2352x1568
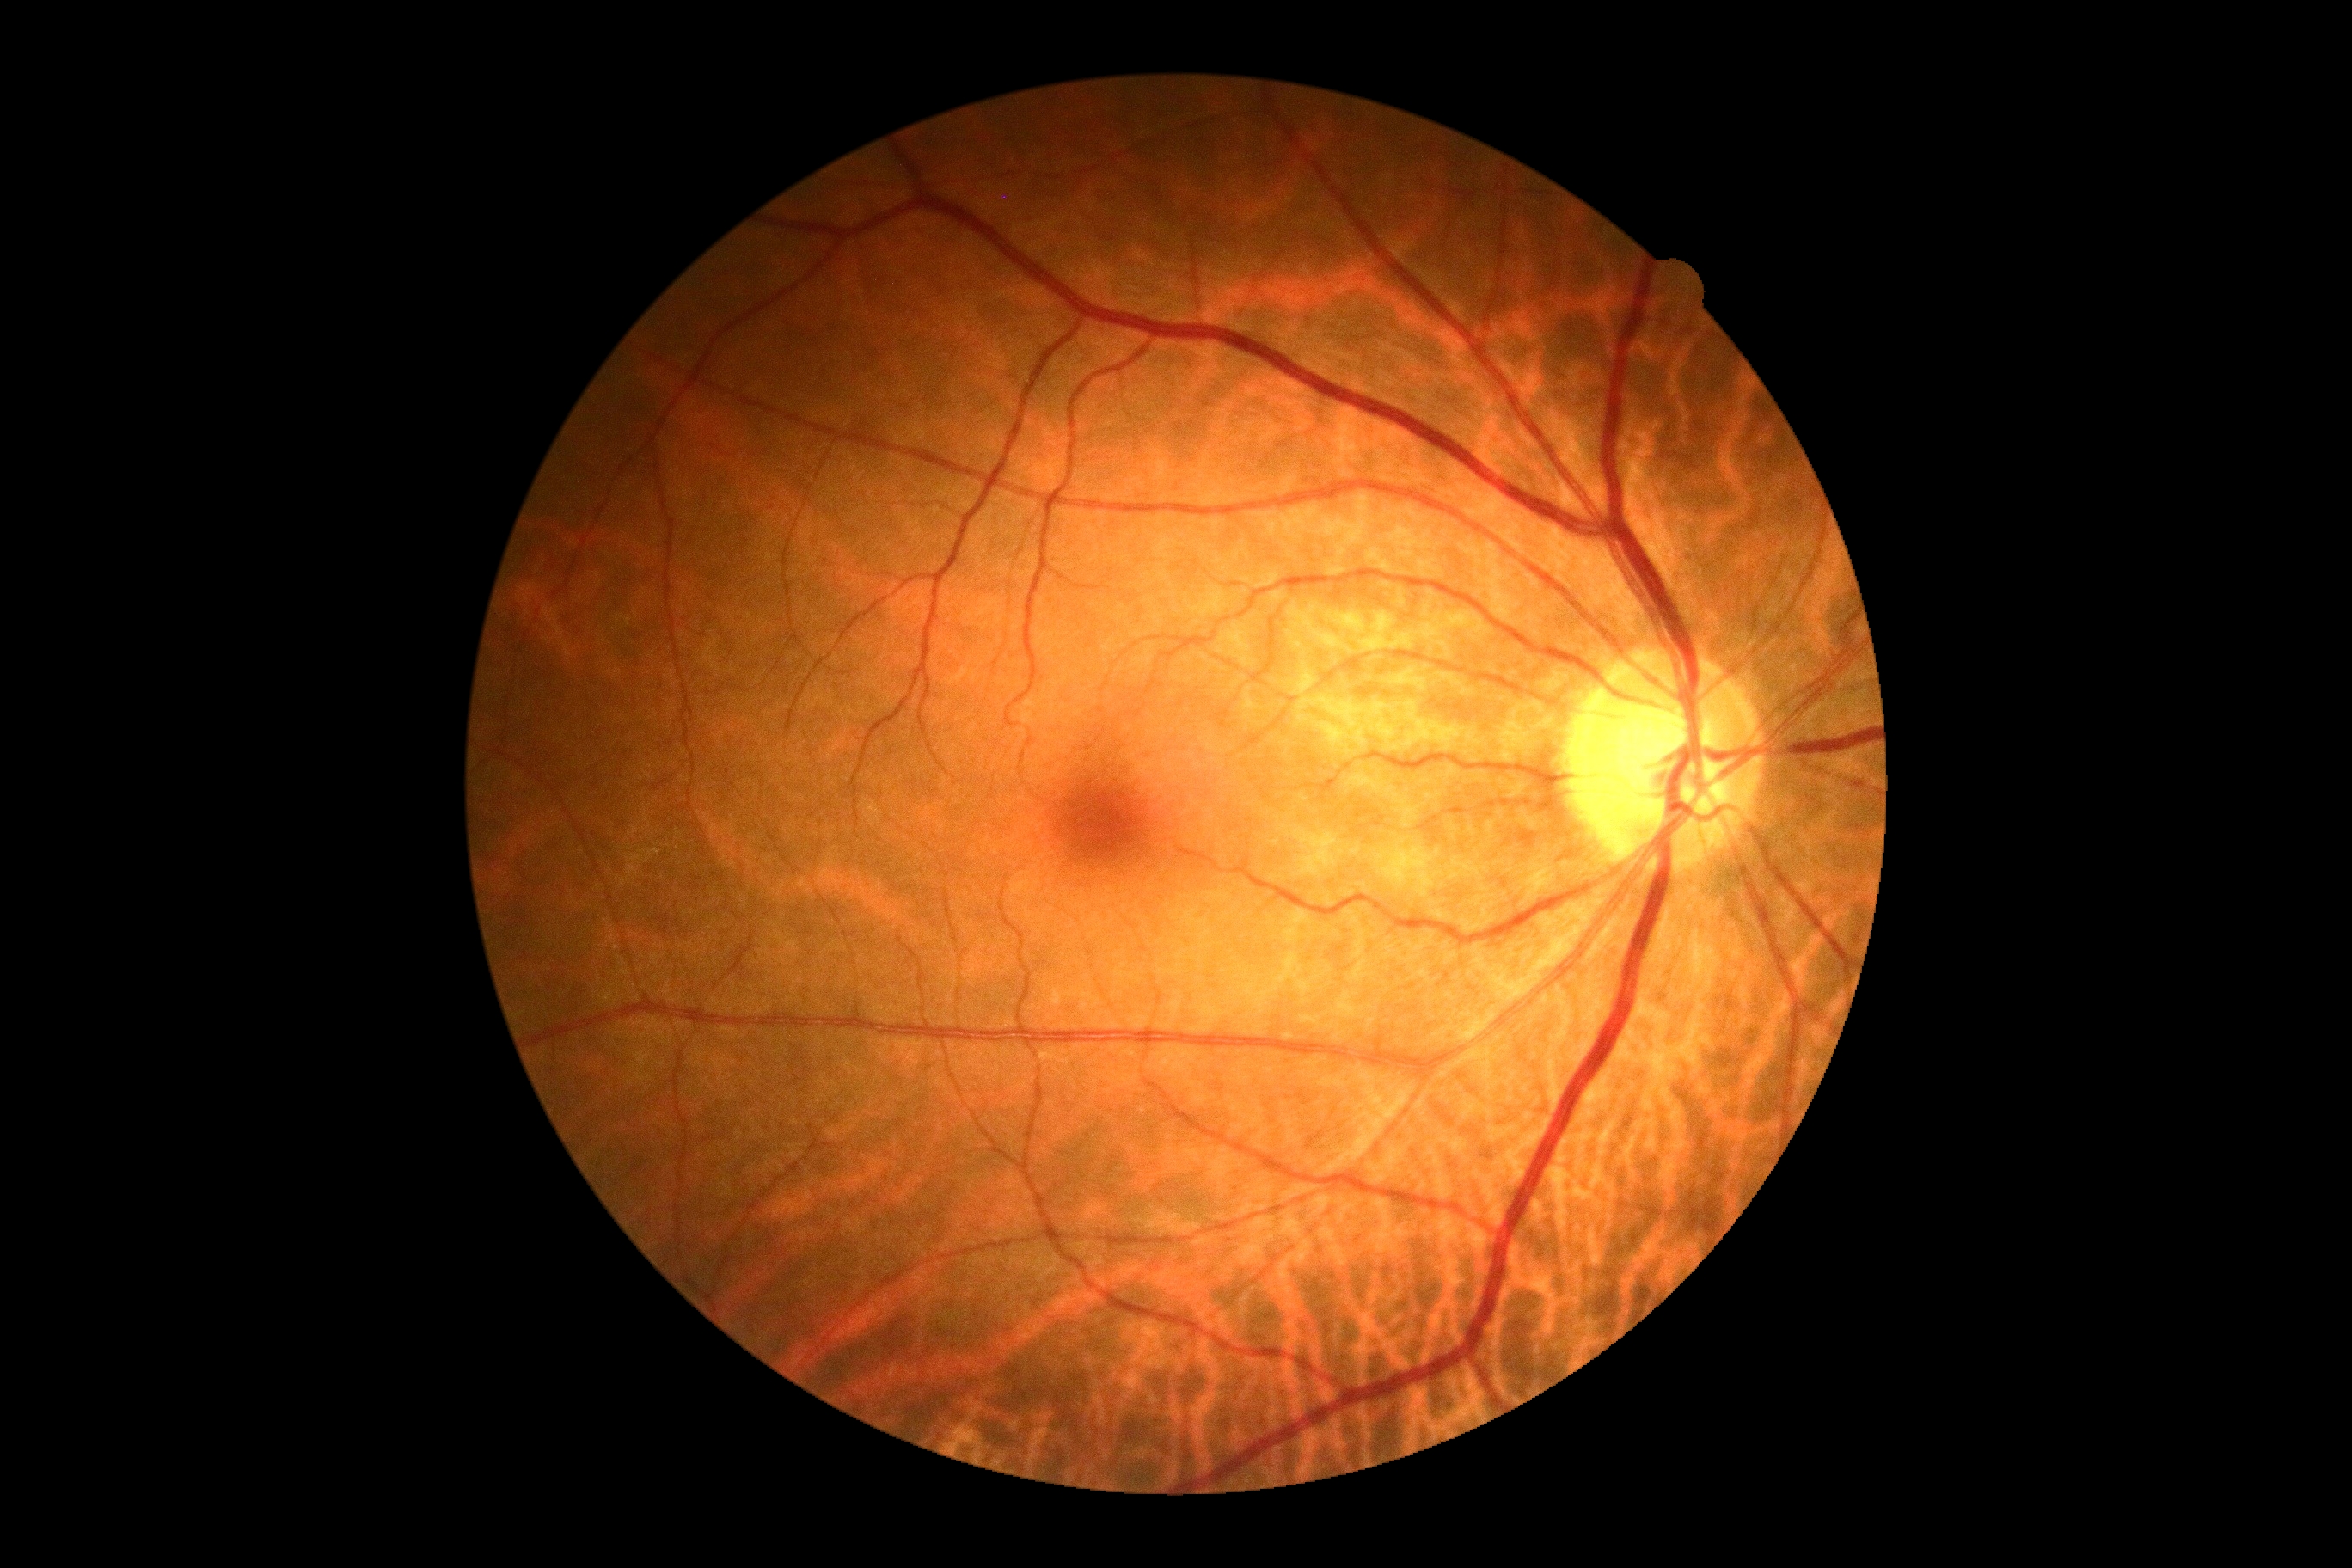

DR severity = 0 | DR impression = no DR findings.